1504 x 1000 pixels — 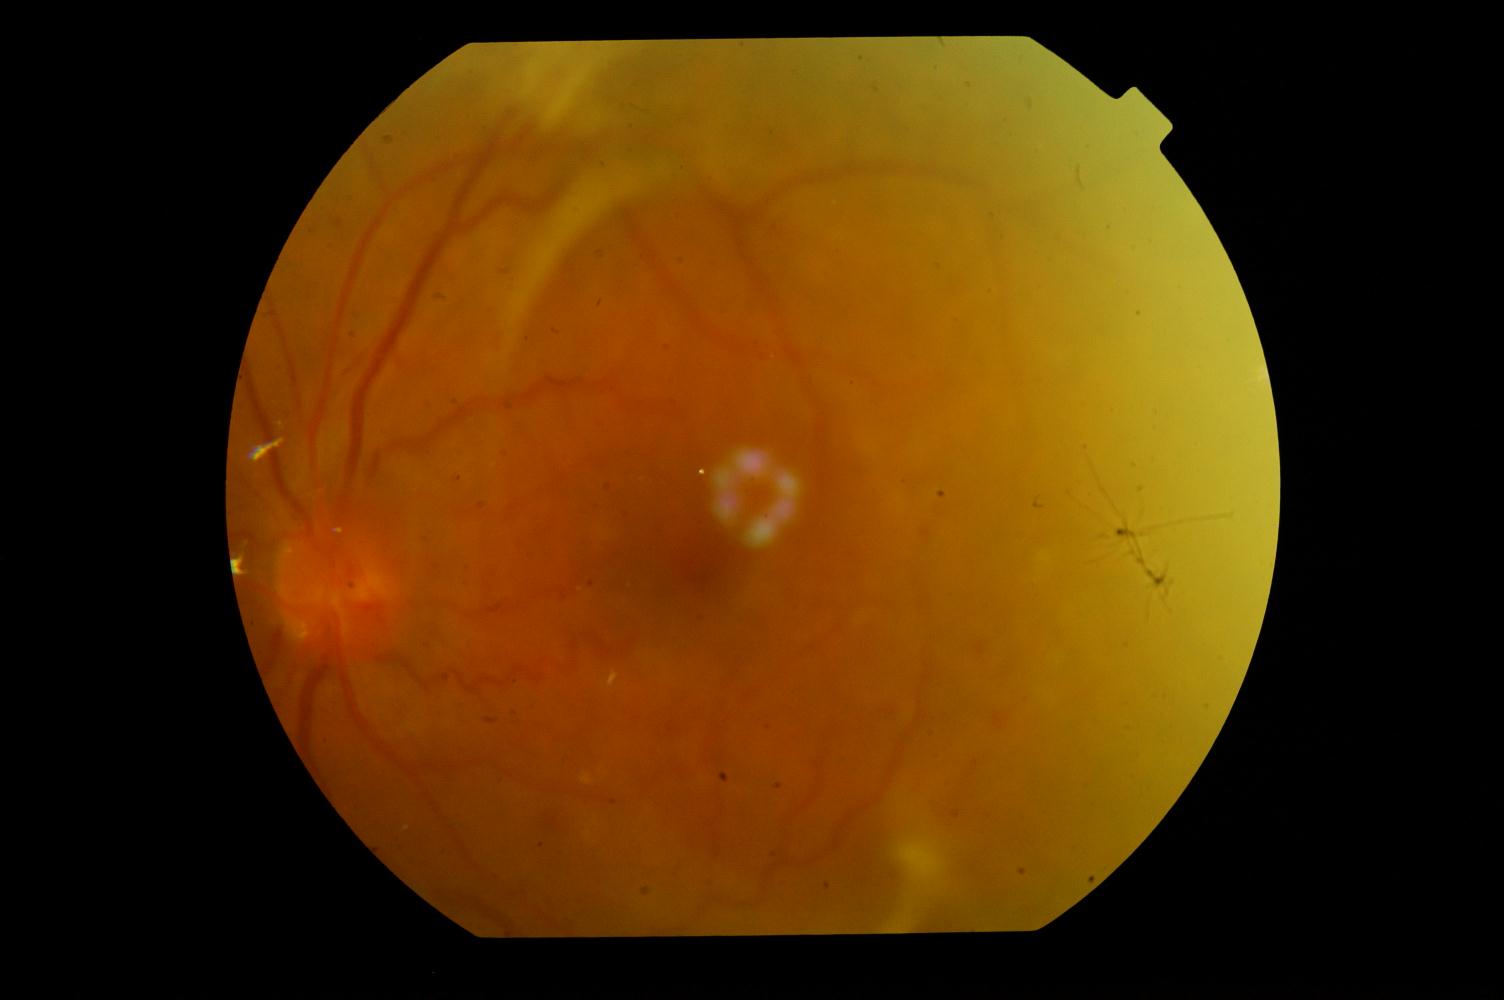

The image shows DR (diabetic retinopathy).